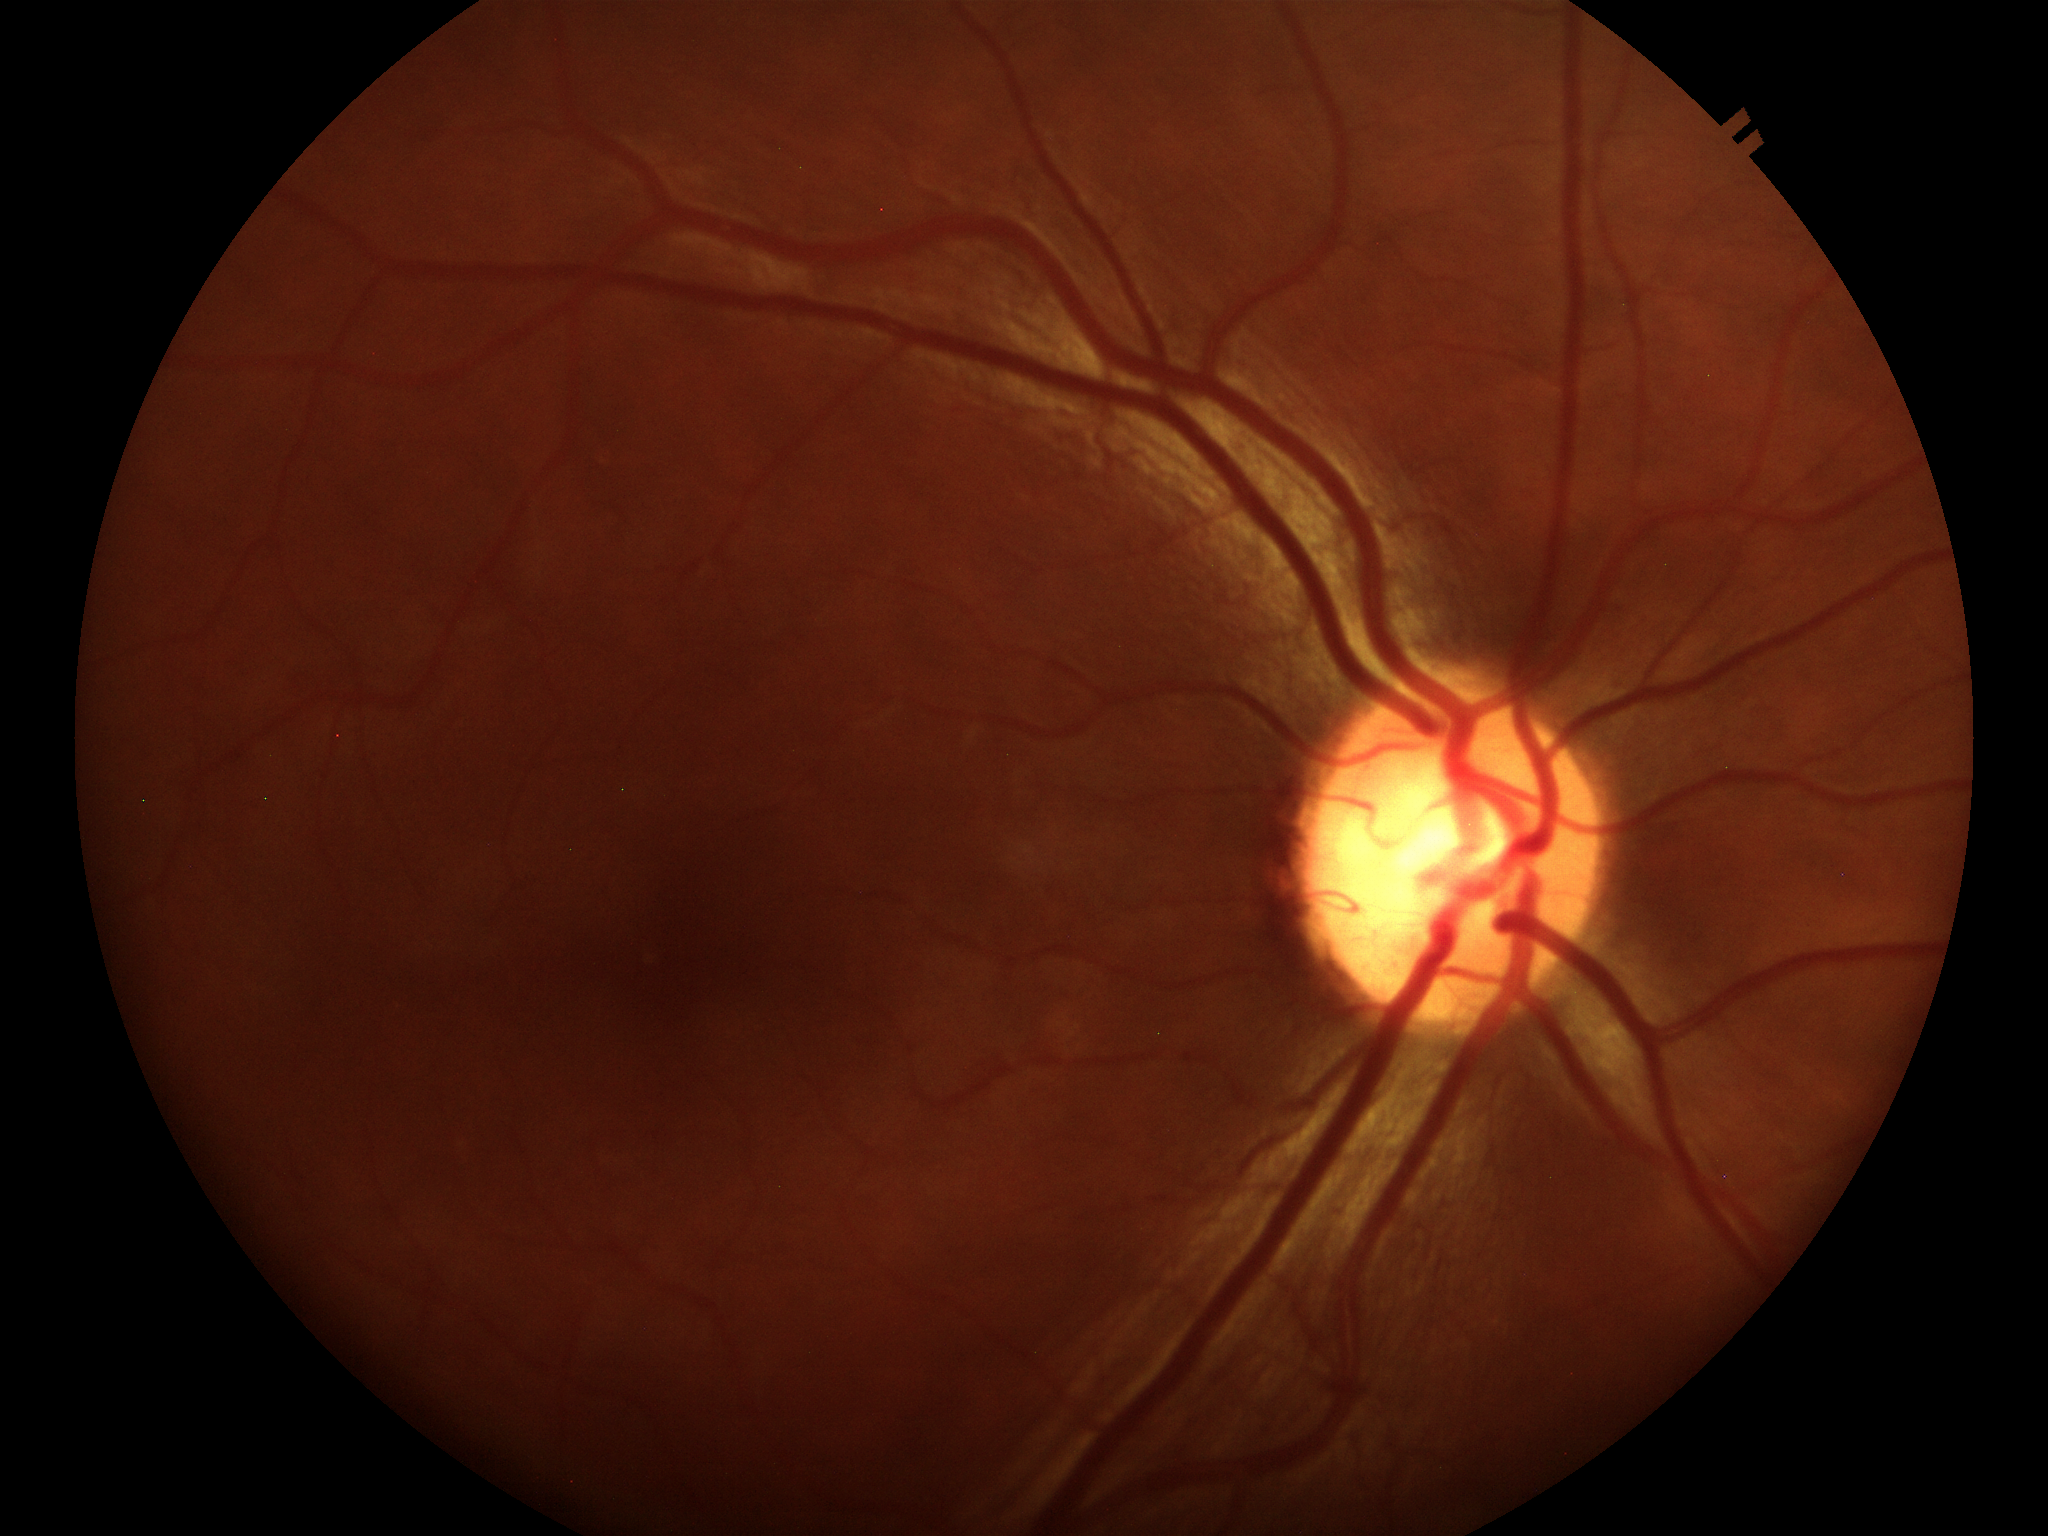 Glaucoma screening=negative (1/5 graders called glaucoma suspect) | vertical cup-disc ratio (VCDR)=0.53 | horizontal CDR (HCDR)=0.57